Infant wide-field fundus photograph.
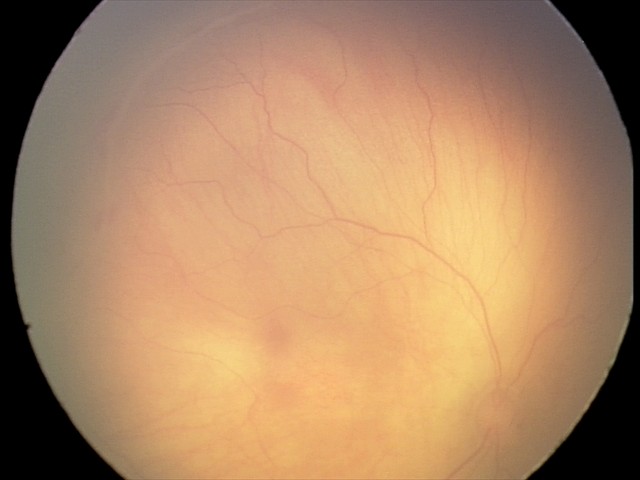
Screening examination consistent with ROP stage 1.